Pediatric wide-field fundus photograph · 130° field of view (Clarity RetCam 3) · 640x480:
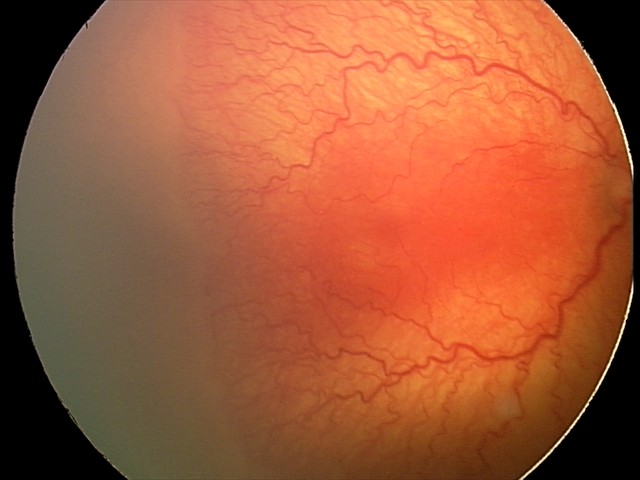 Screening series with aggressive retinopathy of prematurity (A-ROP) — rapidly progressive severe ROP with prominent plus disease, often without classic stage progression. With plus disease.